45-degree field of view, image size 848x848, NIDEK AFC-230, DR severity per modified Davis staging, retinal fundus photograph:
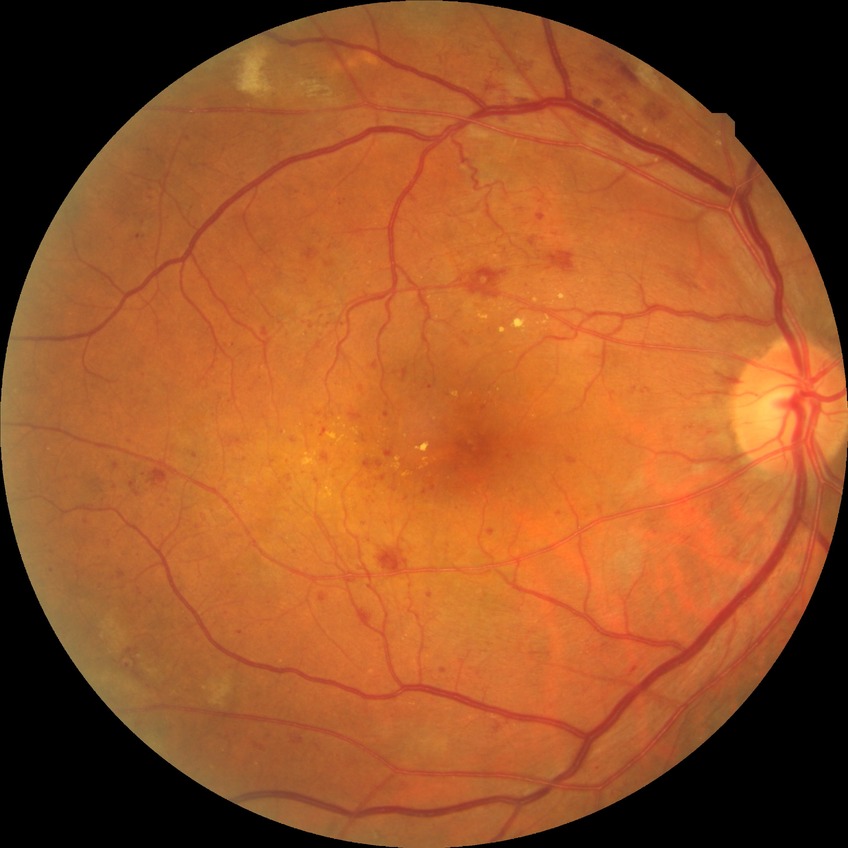 diabetic retinopathy stage: pre-proliferative diabetic retinopathy.